2352 by 1568 pixels. Retinal fundus photograph. 45-degree field of view
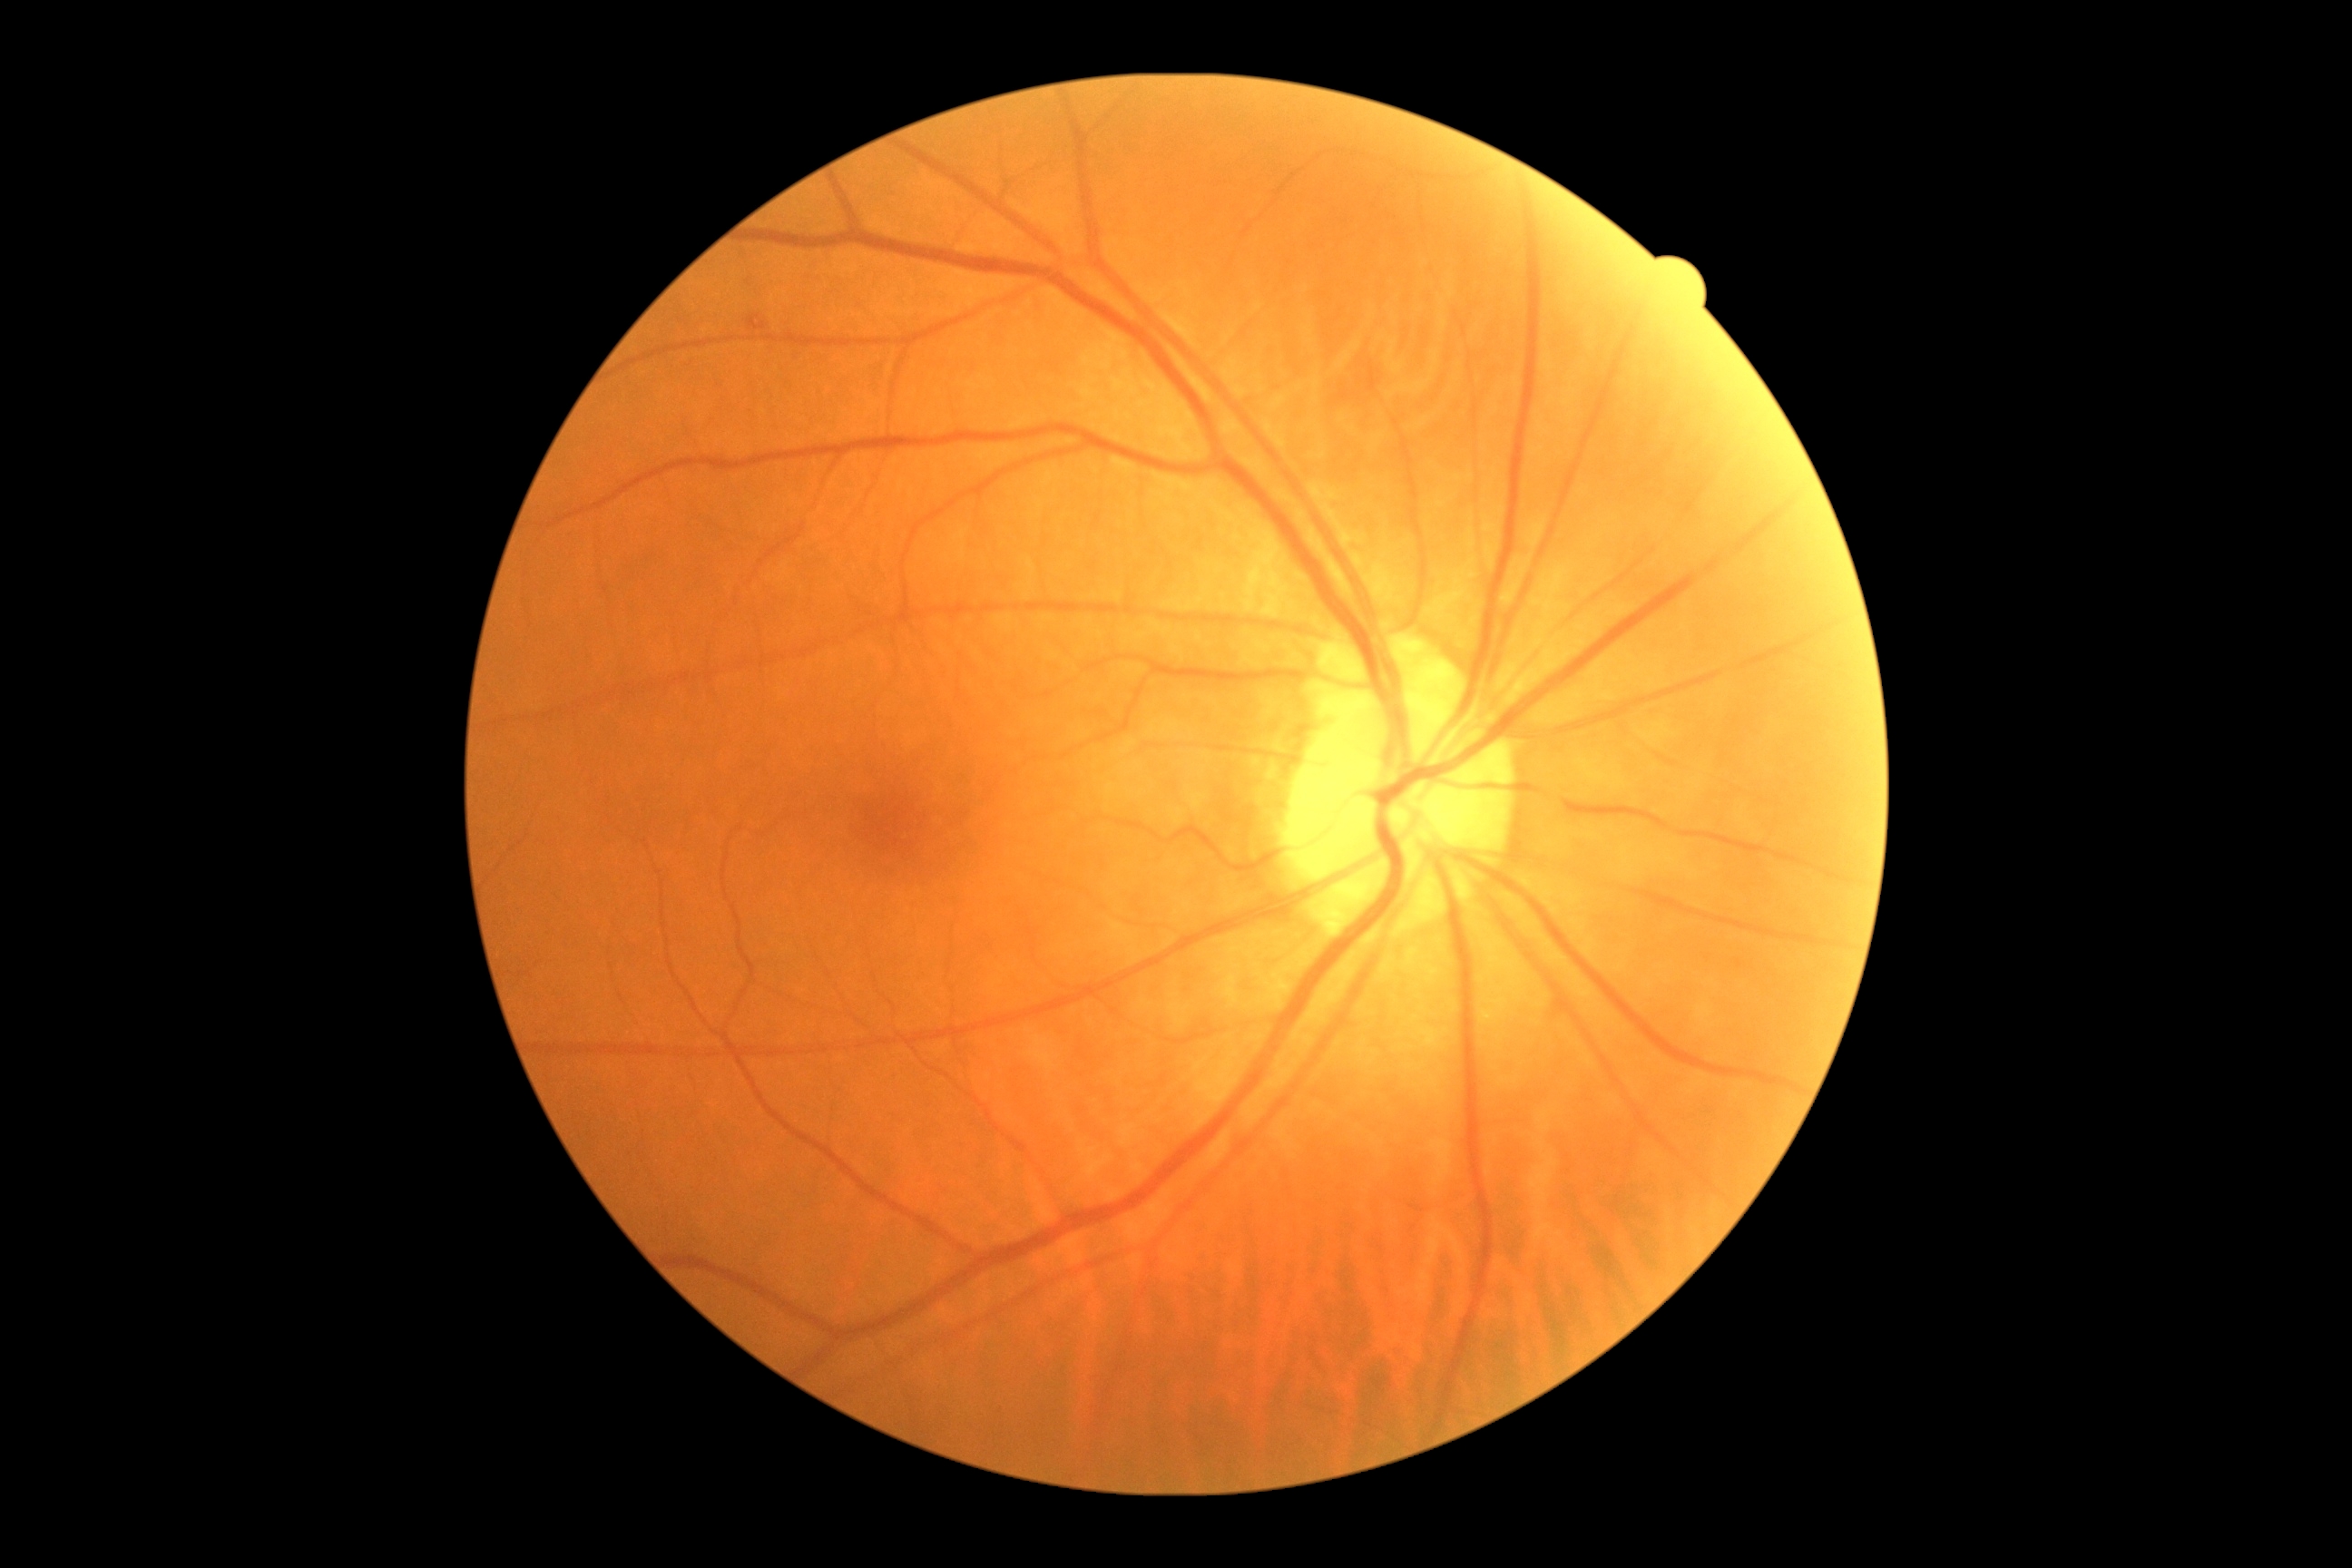 Diabetic retinopathy (DR) is moderate NPDR (grade 2). Disease class: non-proliferative diabetic retinopathy.